Color fundus photograph — 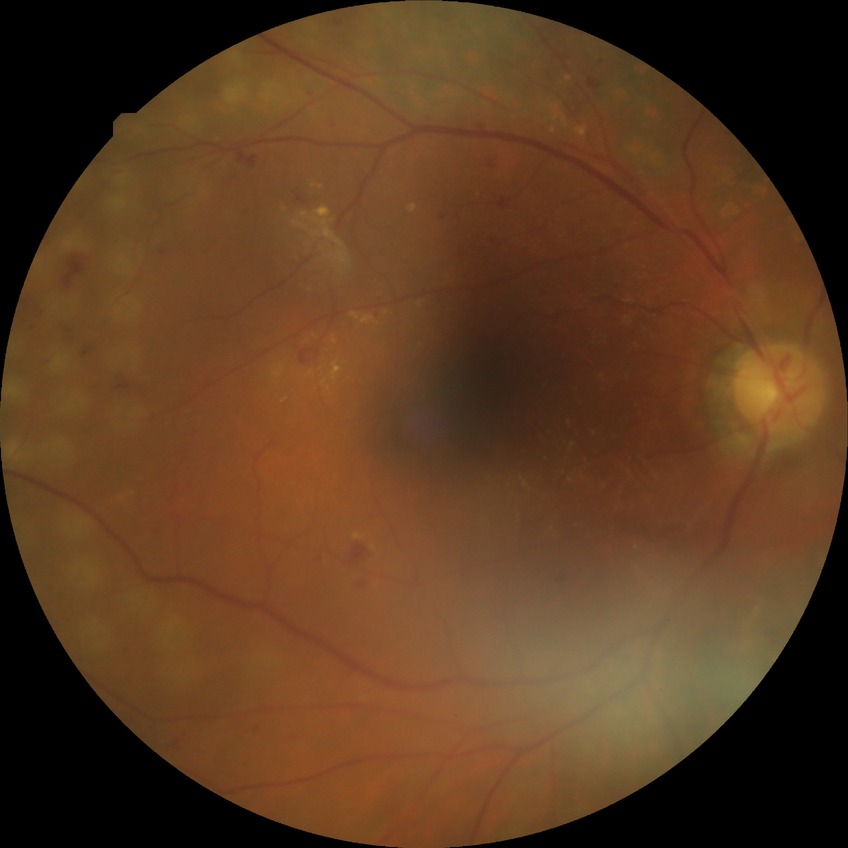 Modified Davis grading is proliferative diabetic retinopathy.